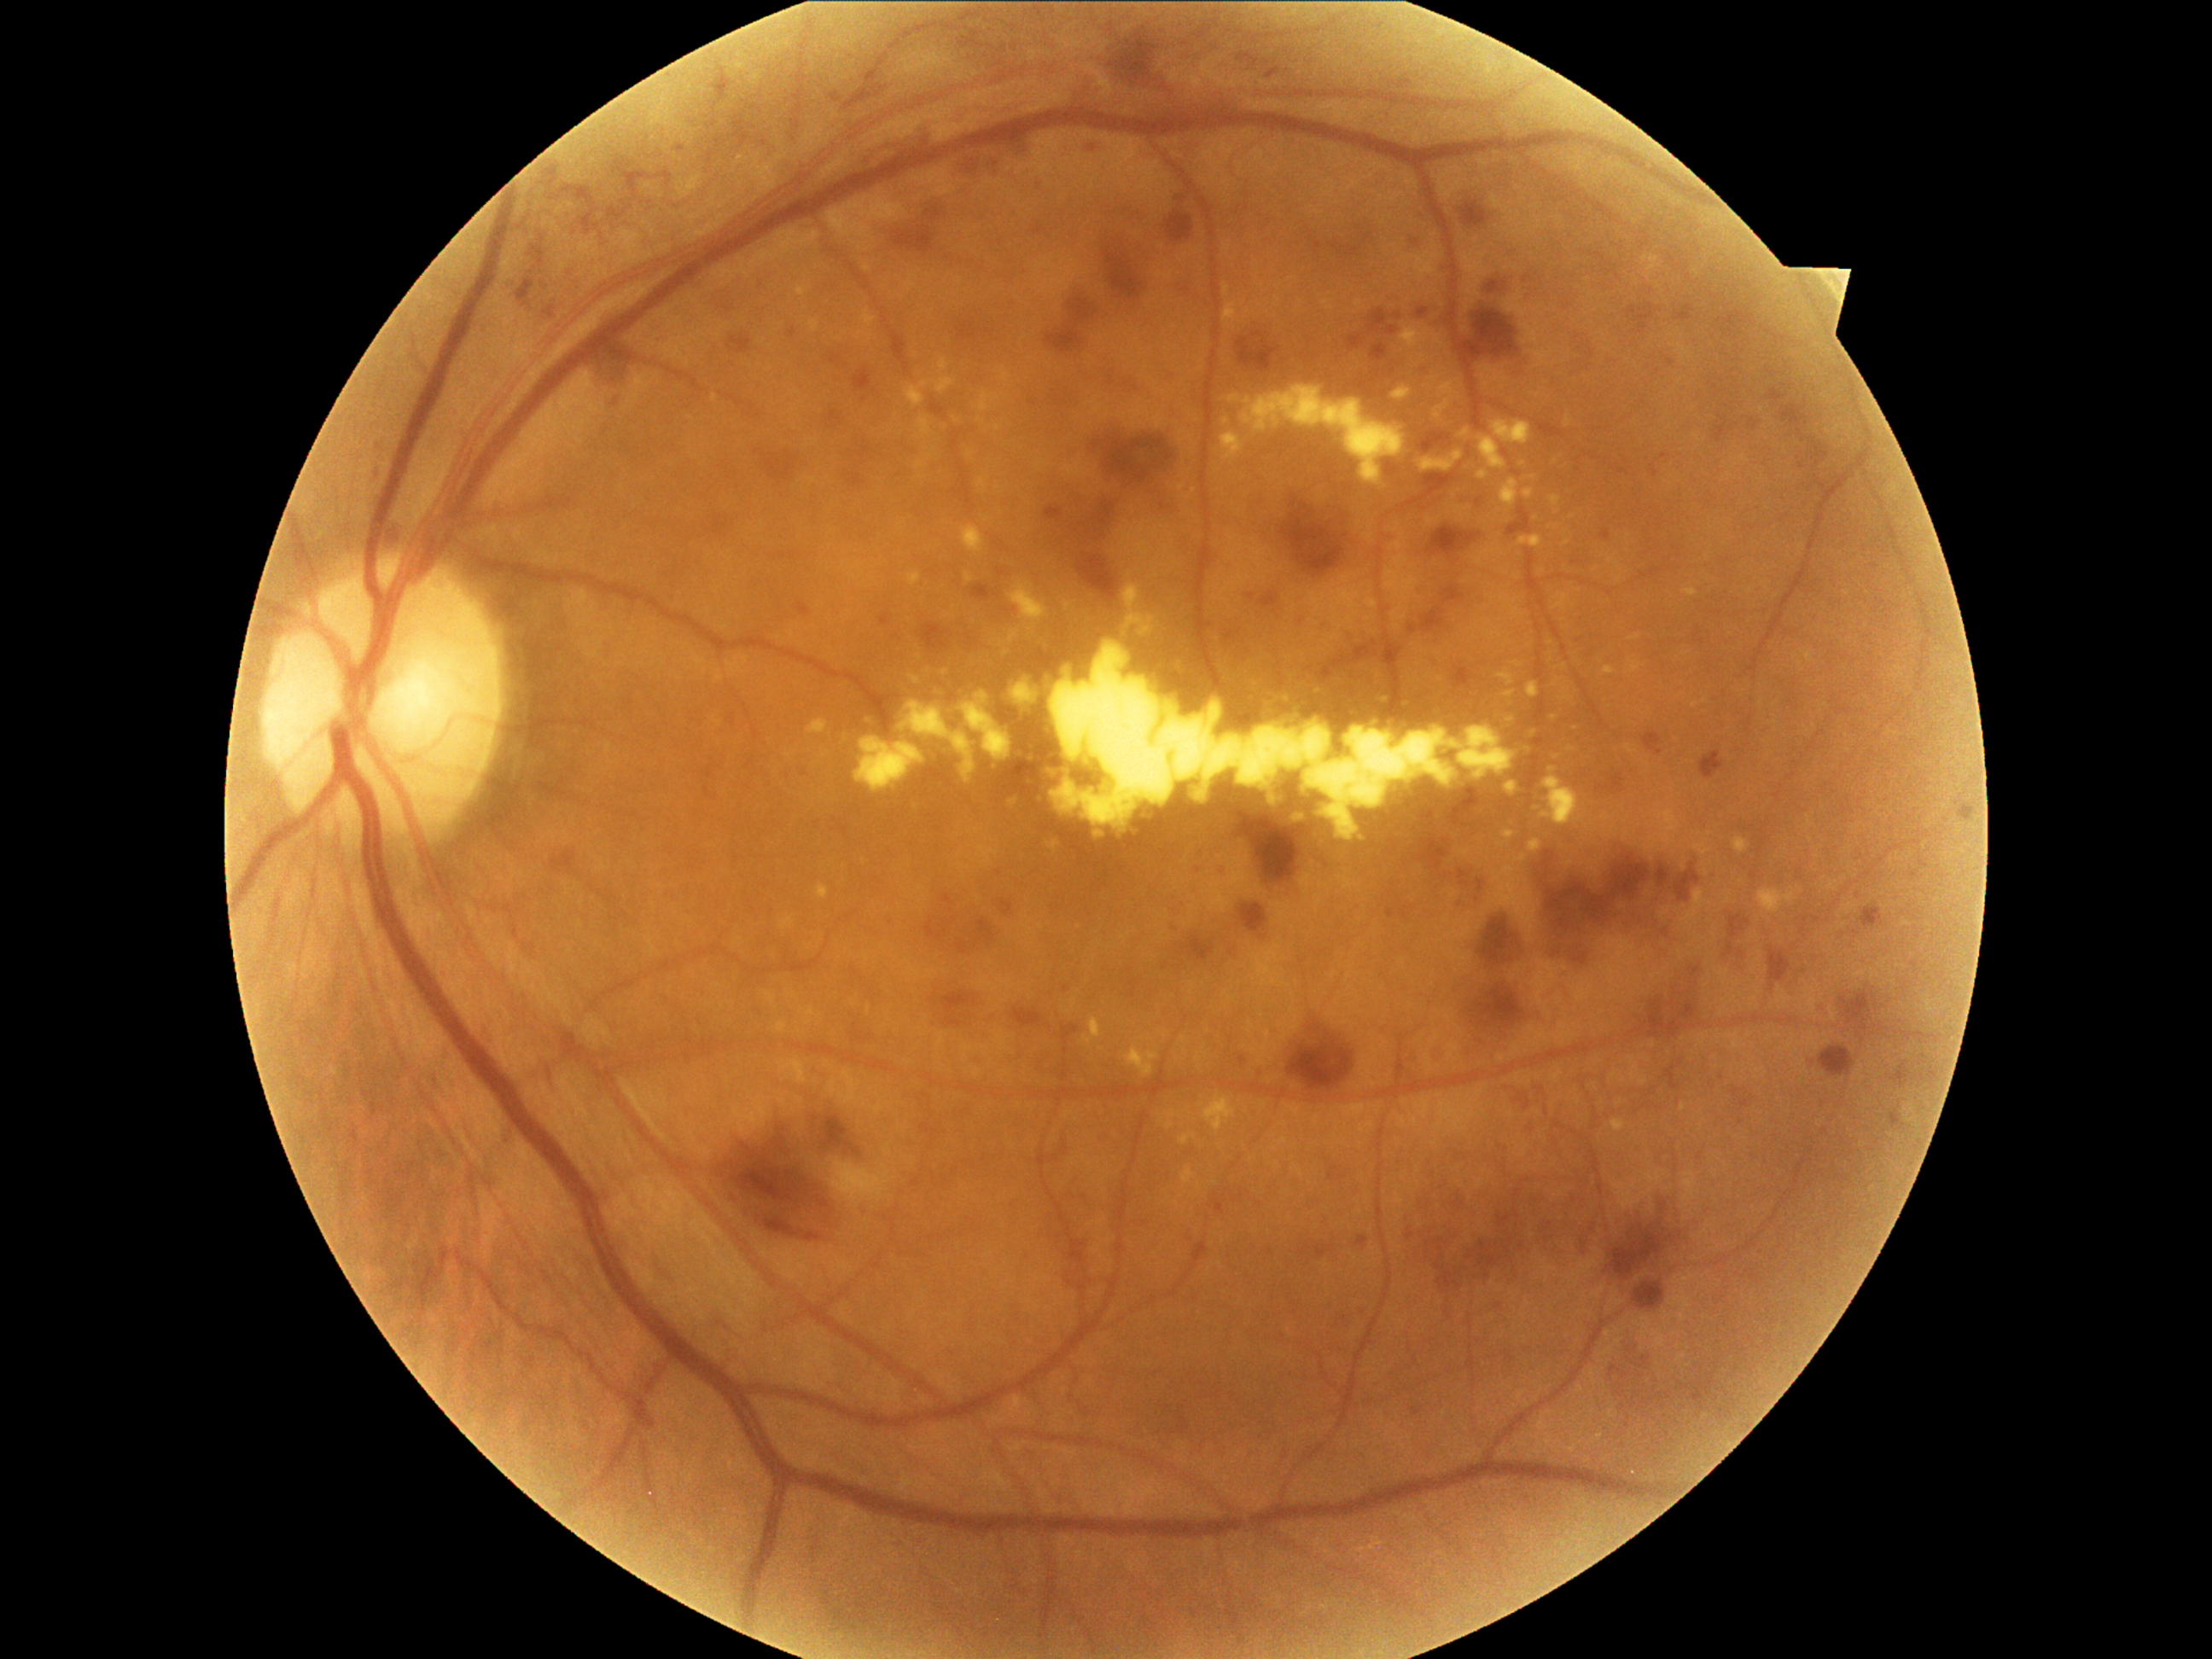 DR grade: 3 (severe NPDR)
Selected lesions:
HEs (subset) = bbox=(755, 450, 798, 489) | bbox=(1336, 1317, 1349, 1329) | bbox=(1090, 194, 1151, 231) | bbox=(1051, 371, 1085, 407) | bbox=(928, 622, 952, 658) | bbox=(1581, 1237, 1588, 1254) | bbox=(1001, 899, 1013, 917) | bbox=(1607, 1197, 1682, 1283) | bbox=(931, 999, 938, 1008) | bbox=(825, 410, 844, 431) | bbox=(1643, 730, 1663, 757) | bbox=(1469, 982, 1527, 1037) | bbox=(1894, 1066, 1907, 1090) | bbox=(1699, 750, 1725, 781) | bbox=(1252, 320, 1274, 363) | bbox=(607, 393, 622, 410)
Small HEs near 1247, 594